Pediatric retinal photograph (wide-field)
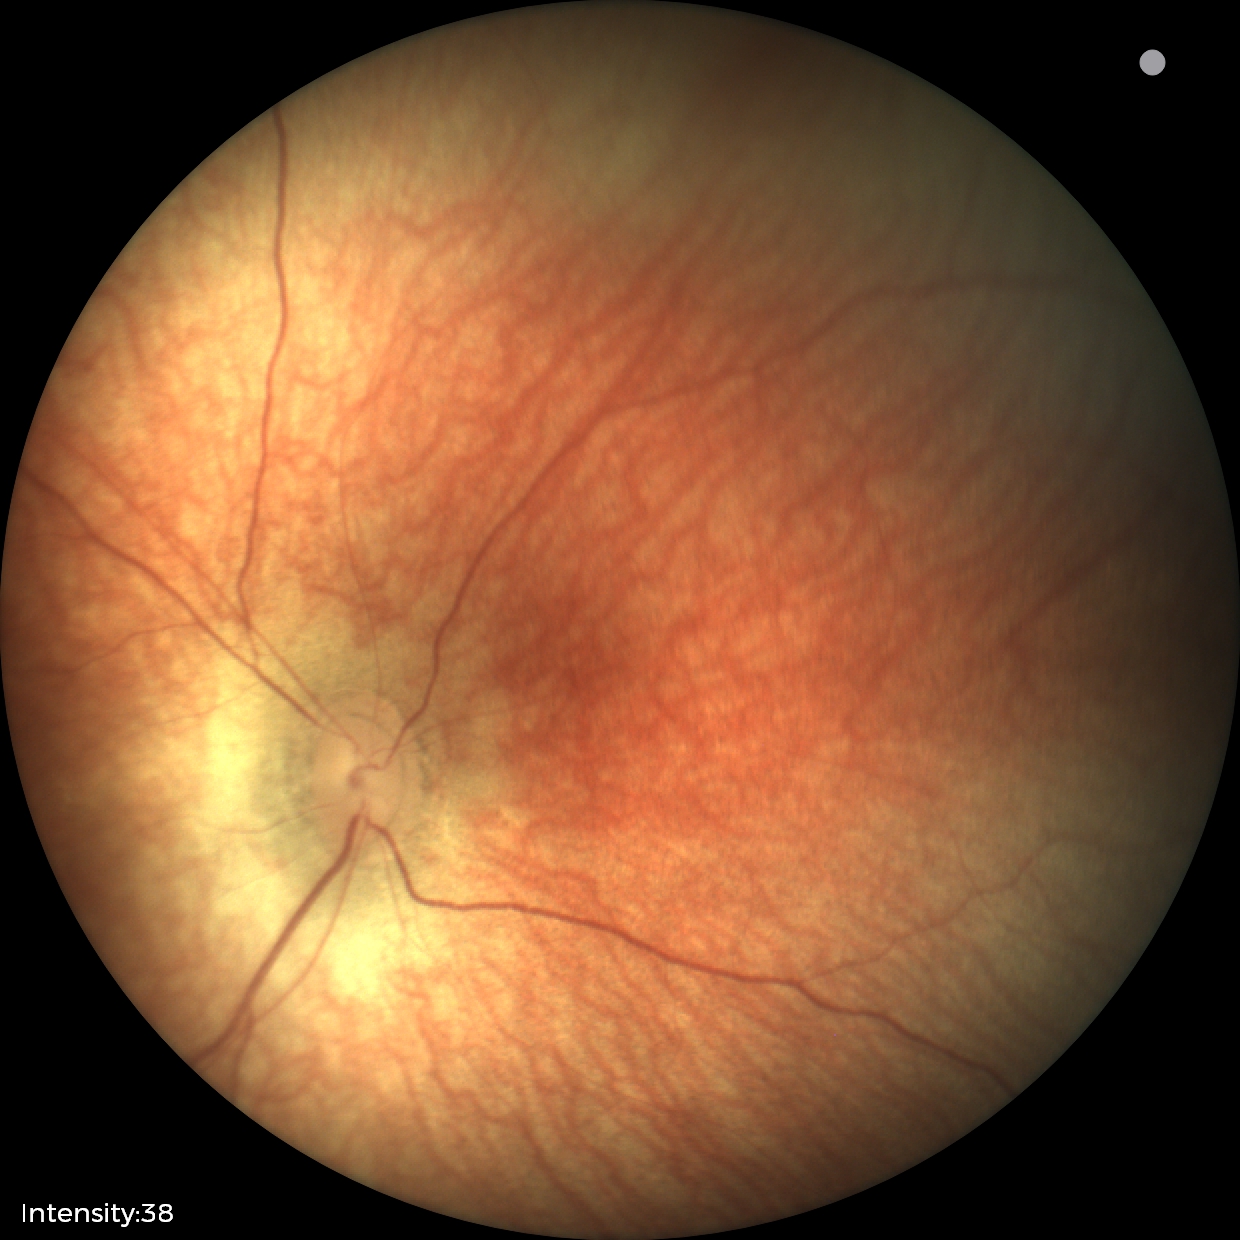

Impression: normal fundus examination.